1380x1382px · retinal fundus photograph · 45-degree field of view
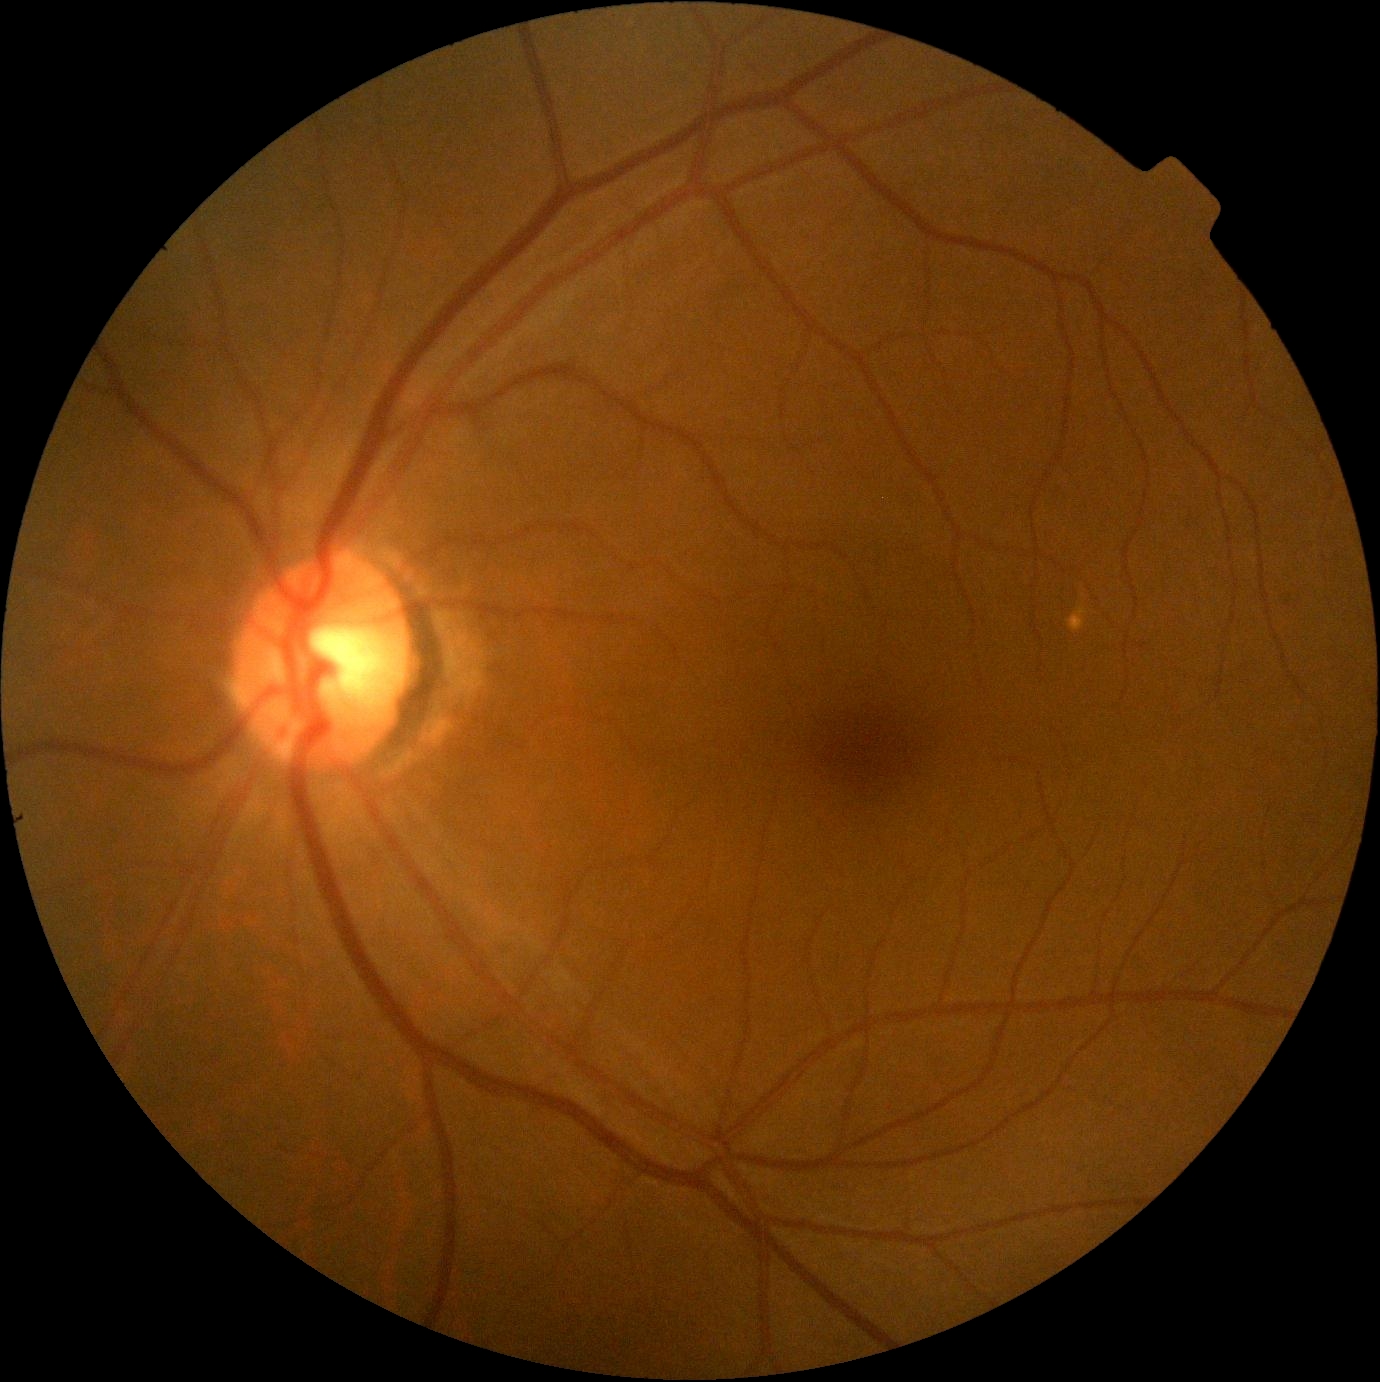
DR stage: grade 0.